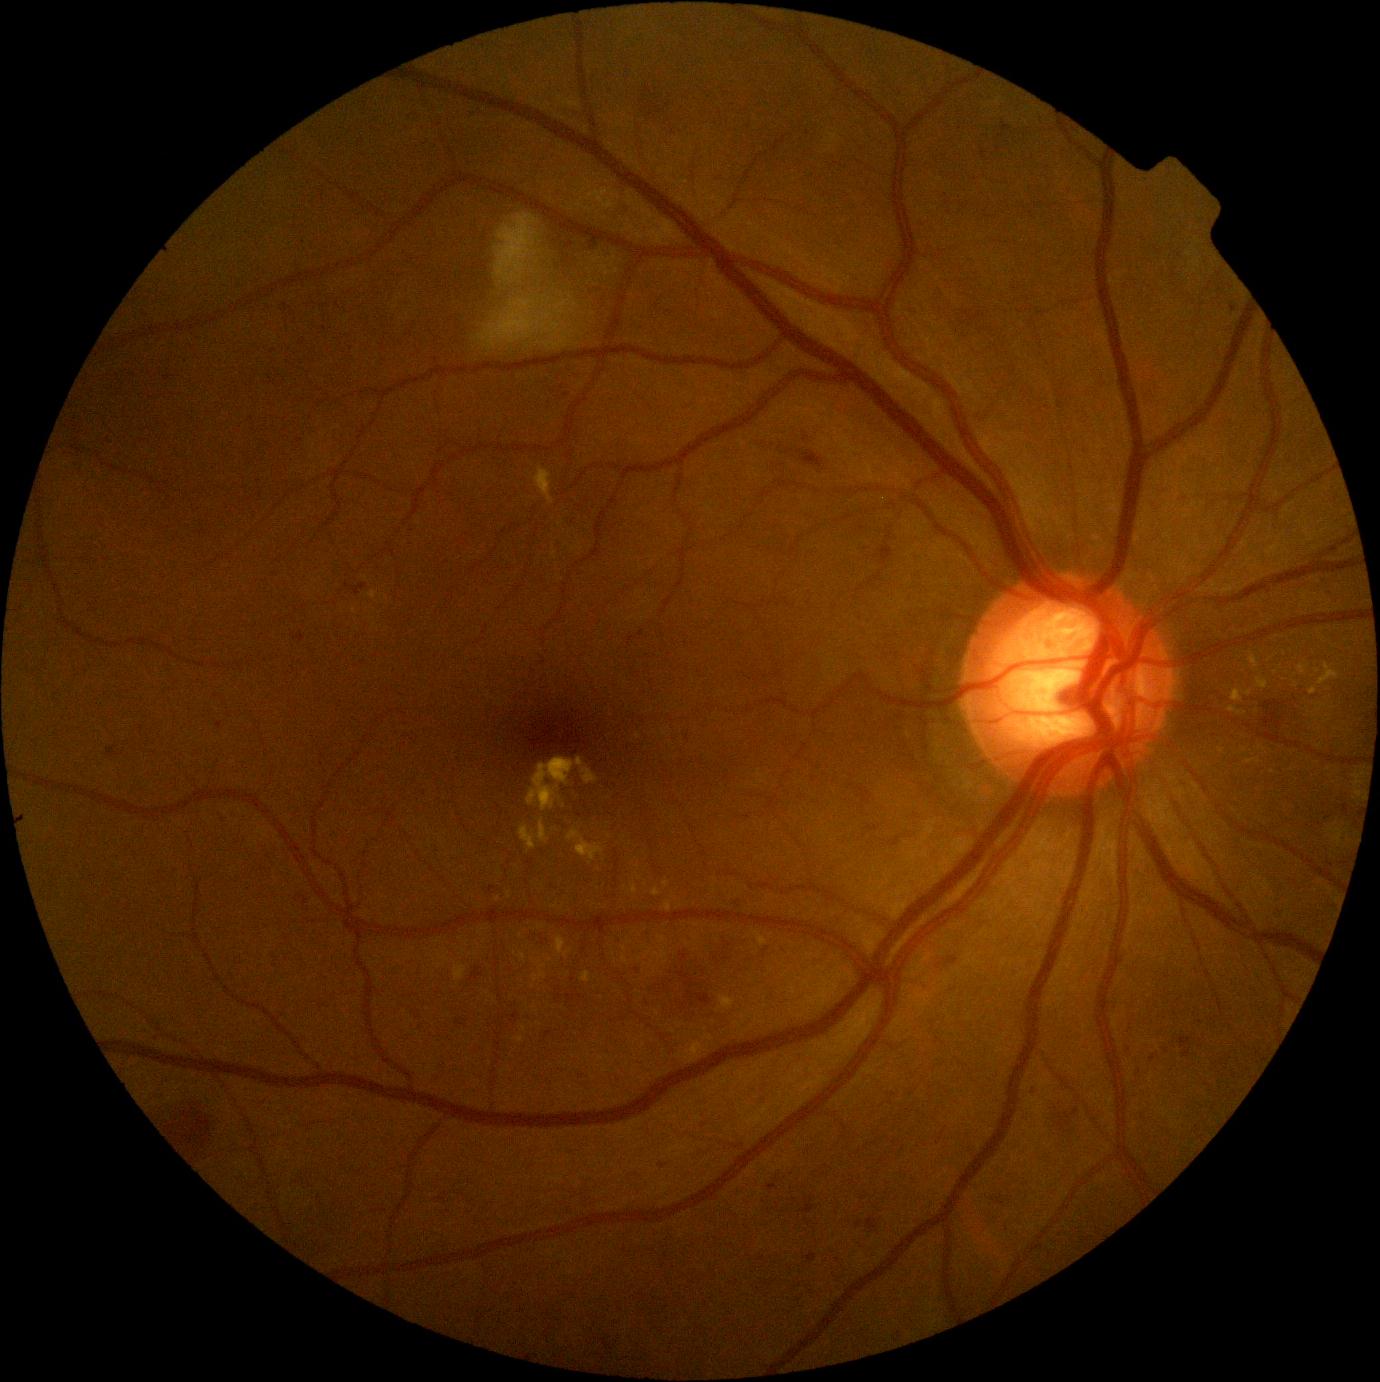
Diabetic retinopathy grade: 2/4; non-proliferative diabetic retinopathy
A subset of detected lesions:
soft exudates: (473,209,581,351)
hard exudates (partial): (583,768,598,785) | (527,758,583,811) | (1249,653,1260,670) | (663,880,669,888) | (1317,704,1326,712) | (1318,662,1340,685) | (664,901,672,912) | (754,931,768,947) | (1245,758,1262,764) | (703,1036,714,1041)
Smaller hard exudates around 638, 867 | 355, 611 | 1317, 671 | 1319, 746 | 1245, 750 | 521, 936
hemorrhages: (1262,694,1294,731) | (757,440,827,470) | (668,953,695,984) | (679,990,713,1016) | (158,1099,220,1158)
microaneurysms (partial): (800,1204,816,1214) | (566,242,574,249) | (659,1162,668,1169) | (878,542,894,565) | (107,747,118,758) | (948,957,959,965) | (590,245,598,250) | (1184,1049,1192,1058) | (768,1185,777,1191) | (867,1218,879,1232) | (1002,121,1011,132)
Smaller microaneurysms around 984, 154 | 1129, 1050 | 748, 817 | 1233, 309